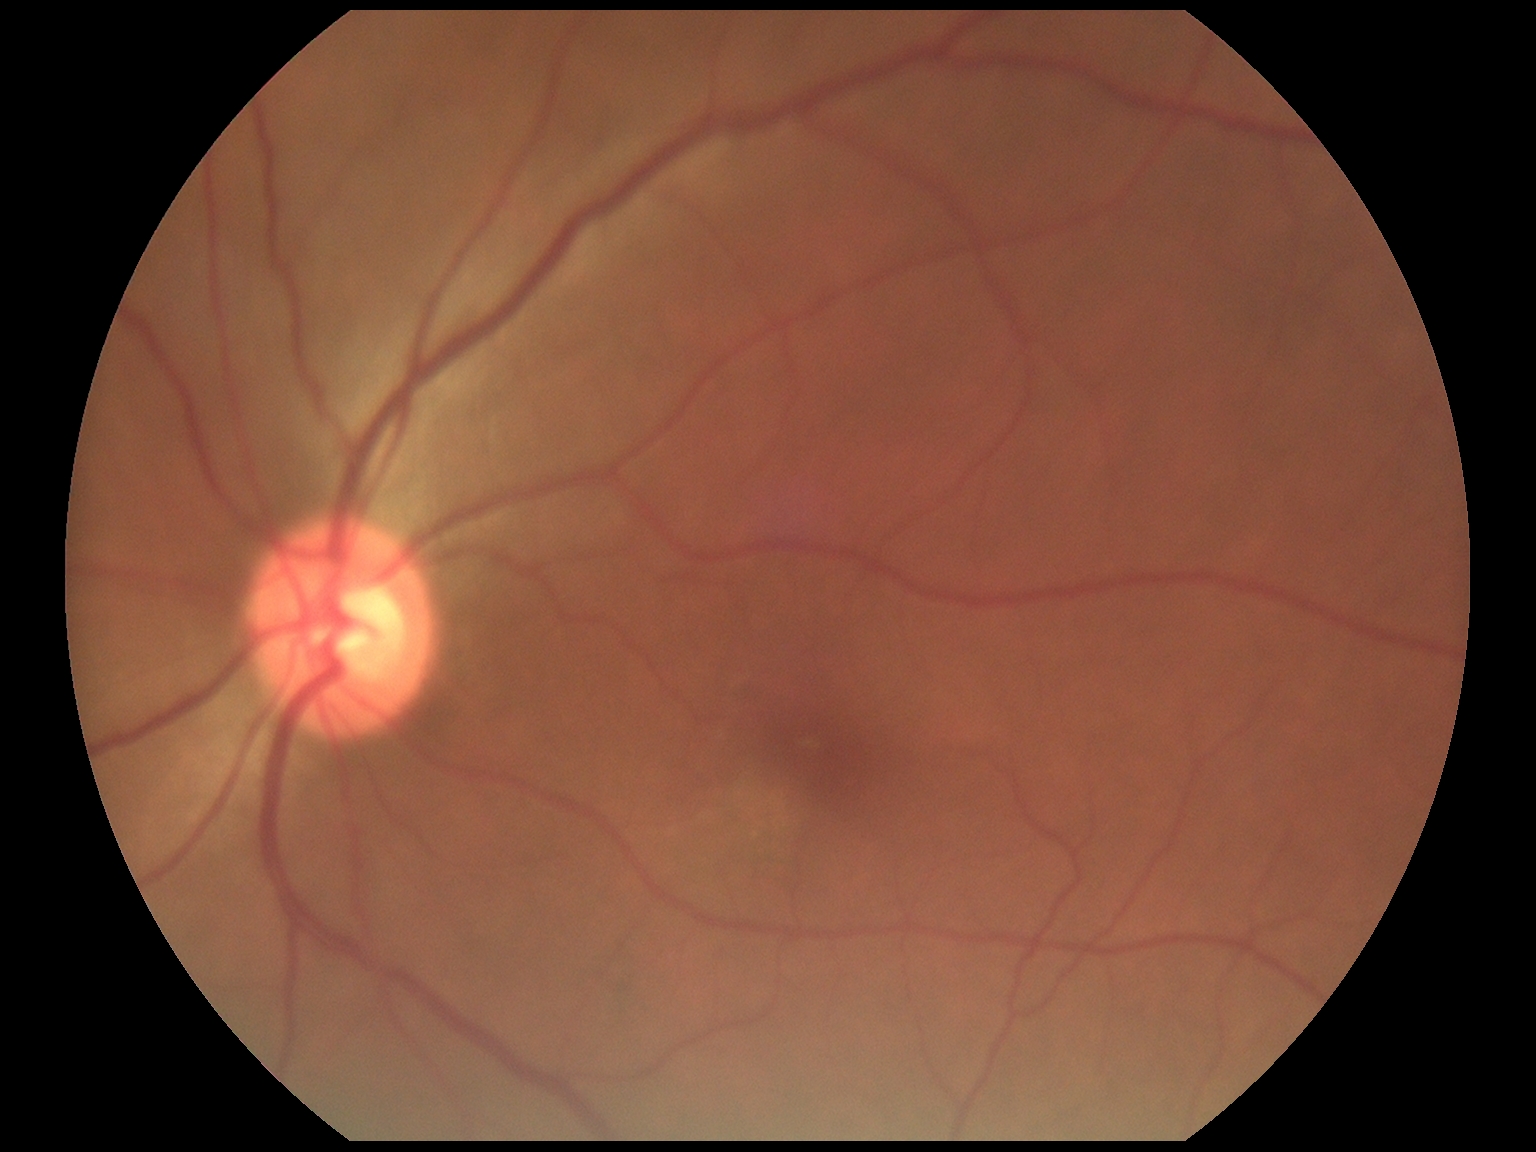 DR: grade 0.